Phoenix ICON wide-field infant fundus image · 100° field of view (Phoenix ICON): 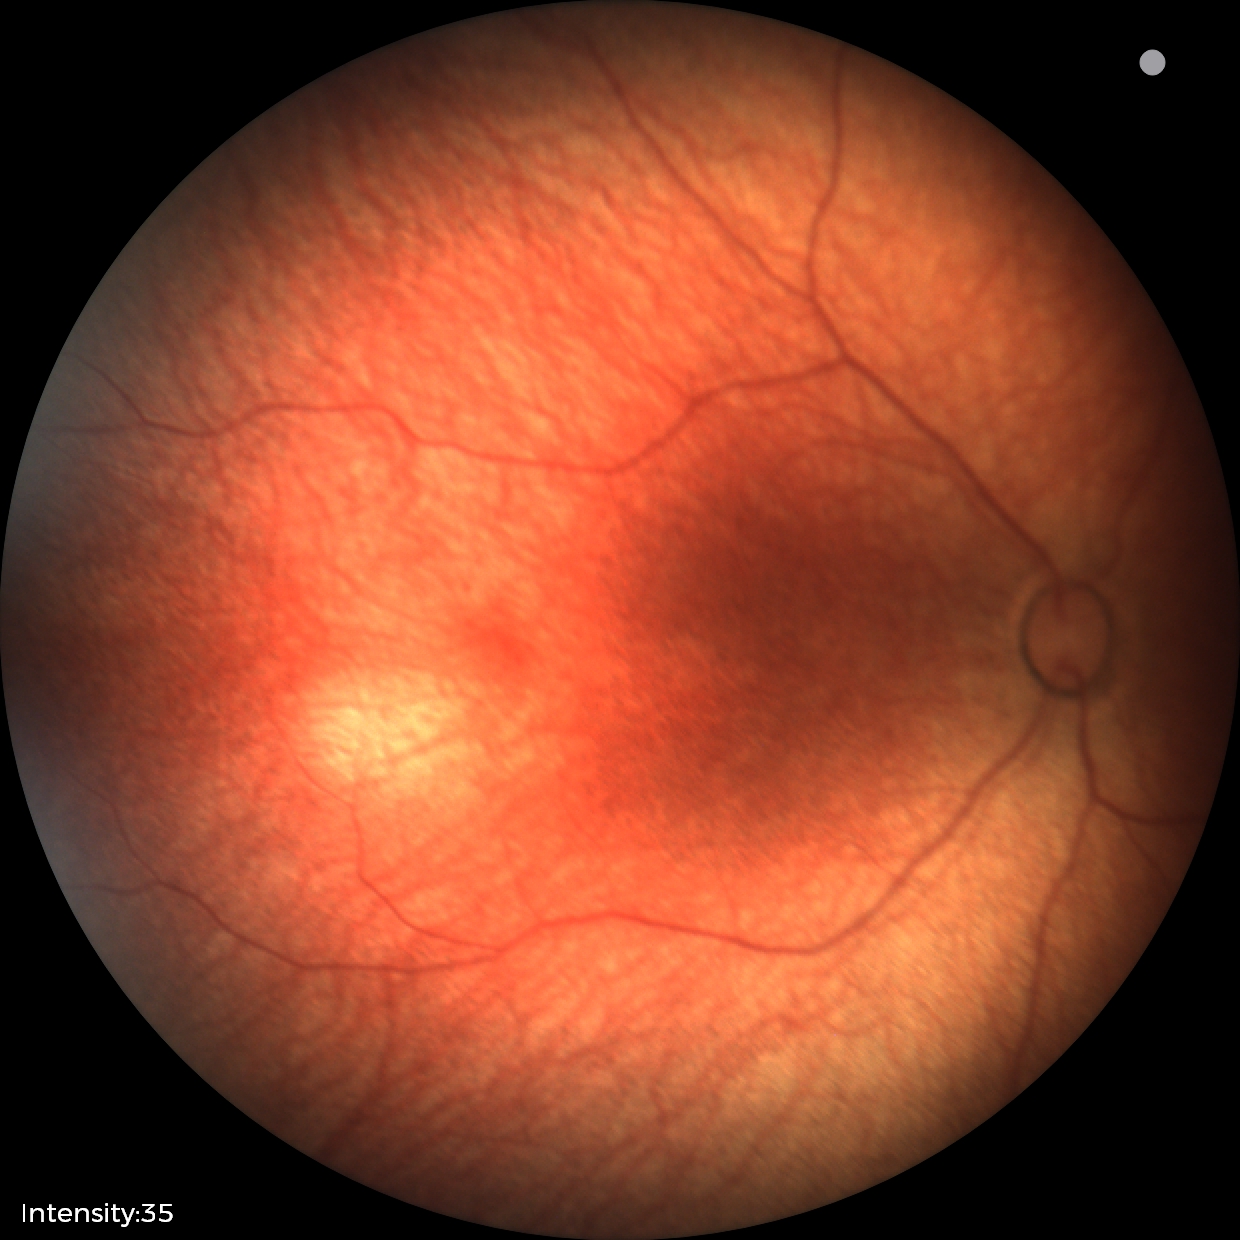
Screening examination diagnosed as physiological.